CFP · 45° field of view · 848 x 848 pixels · without pupil dilation
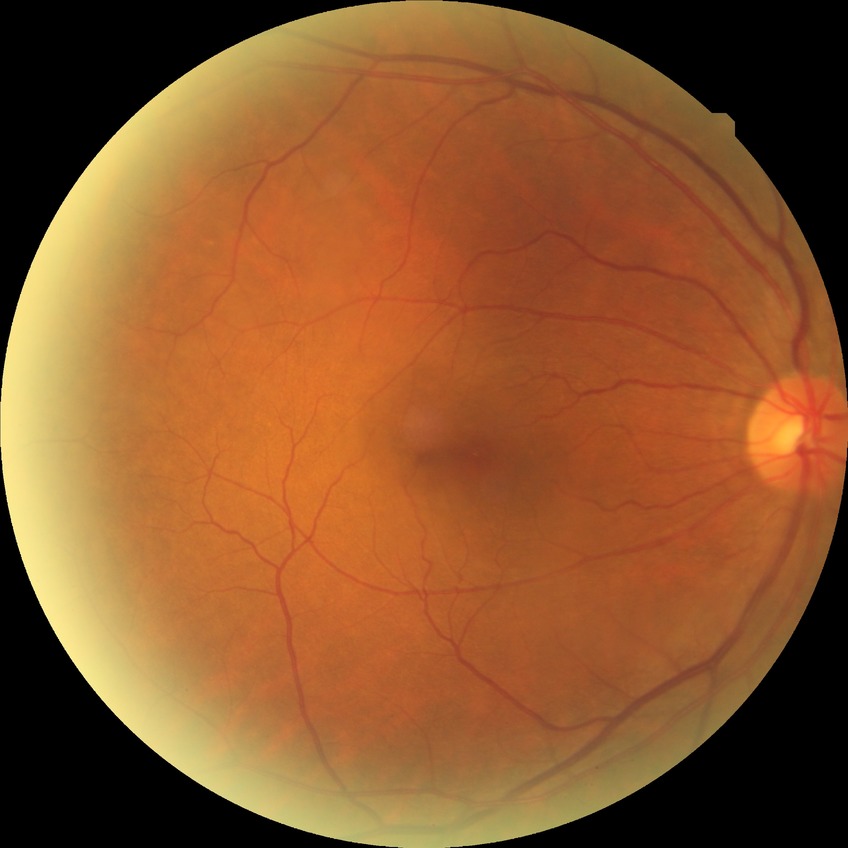

DR: NDR.